2212x1659: 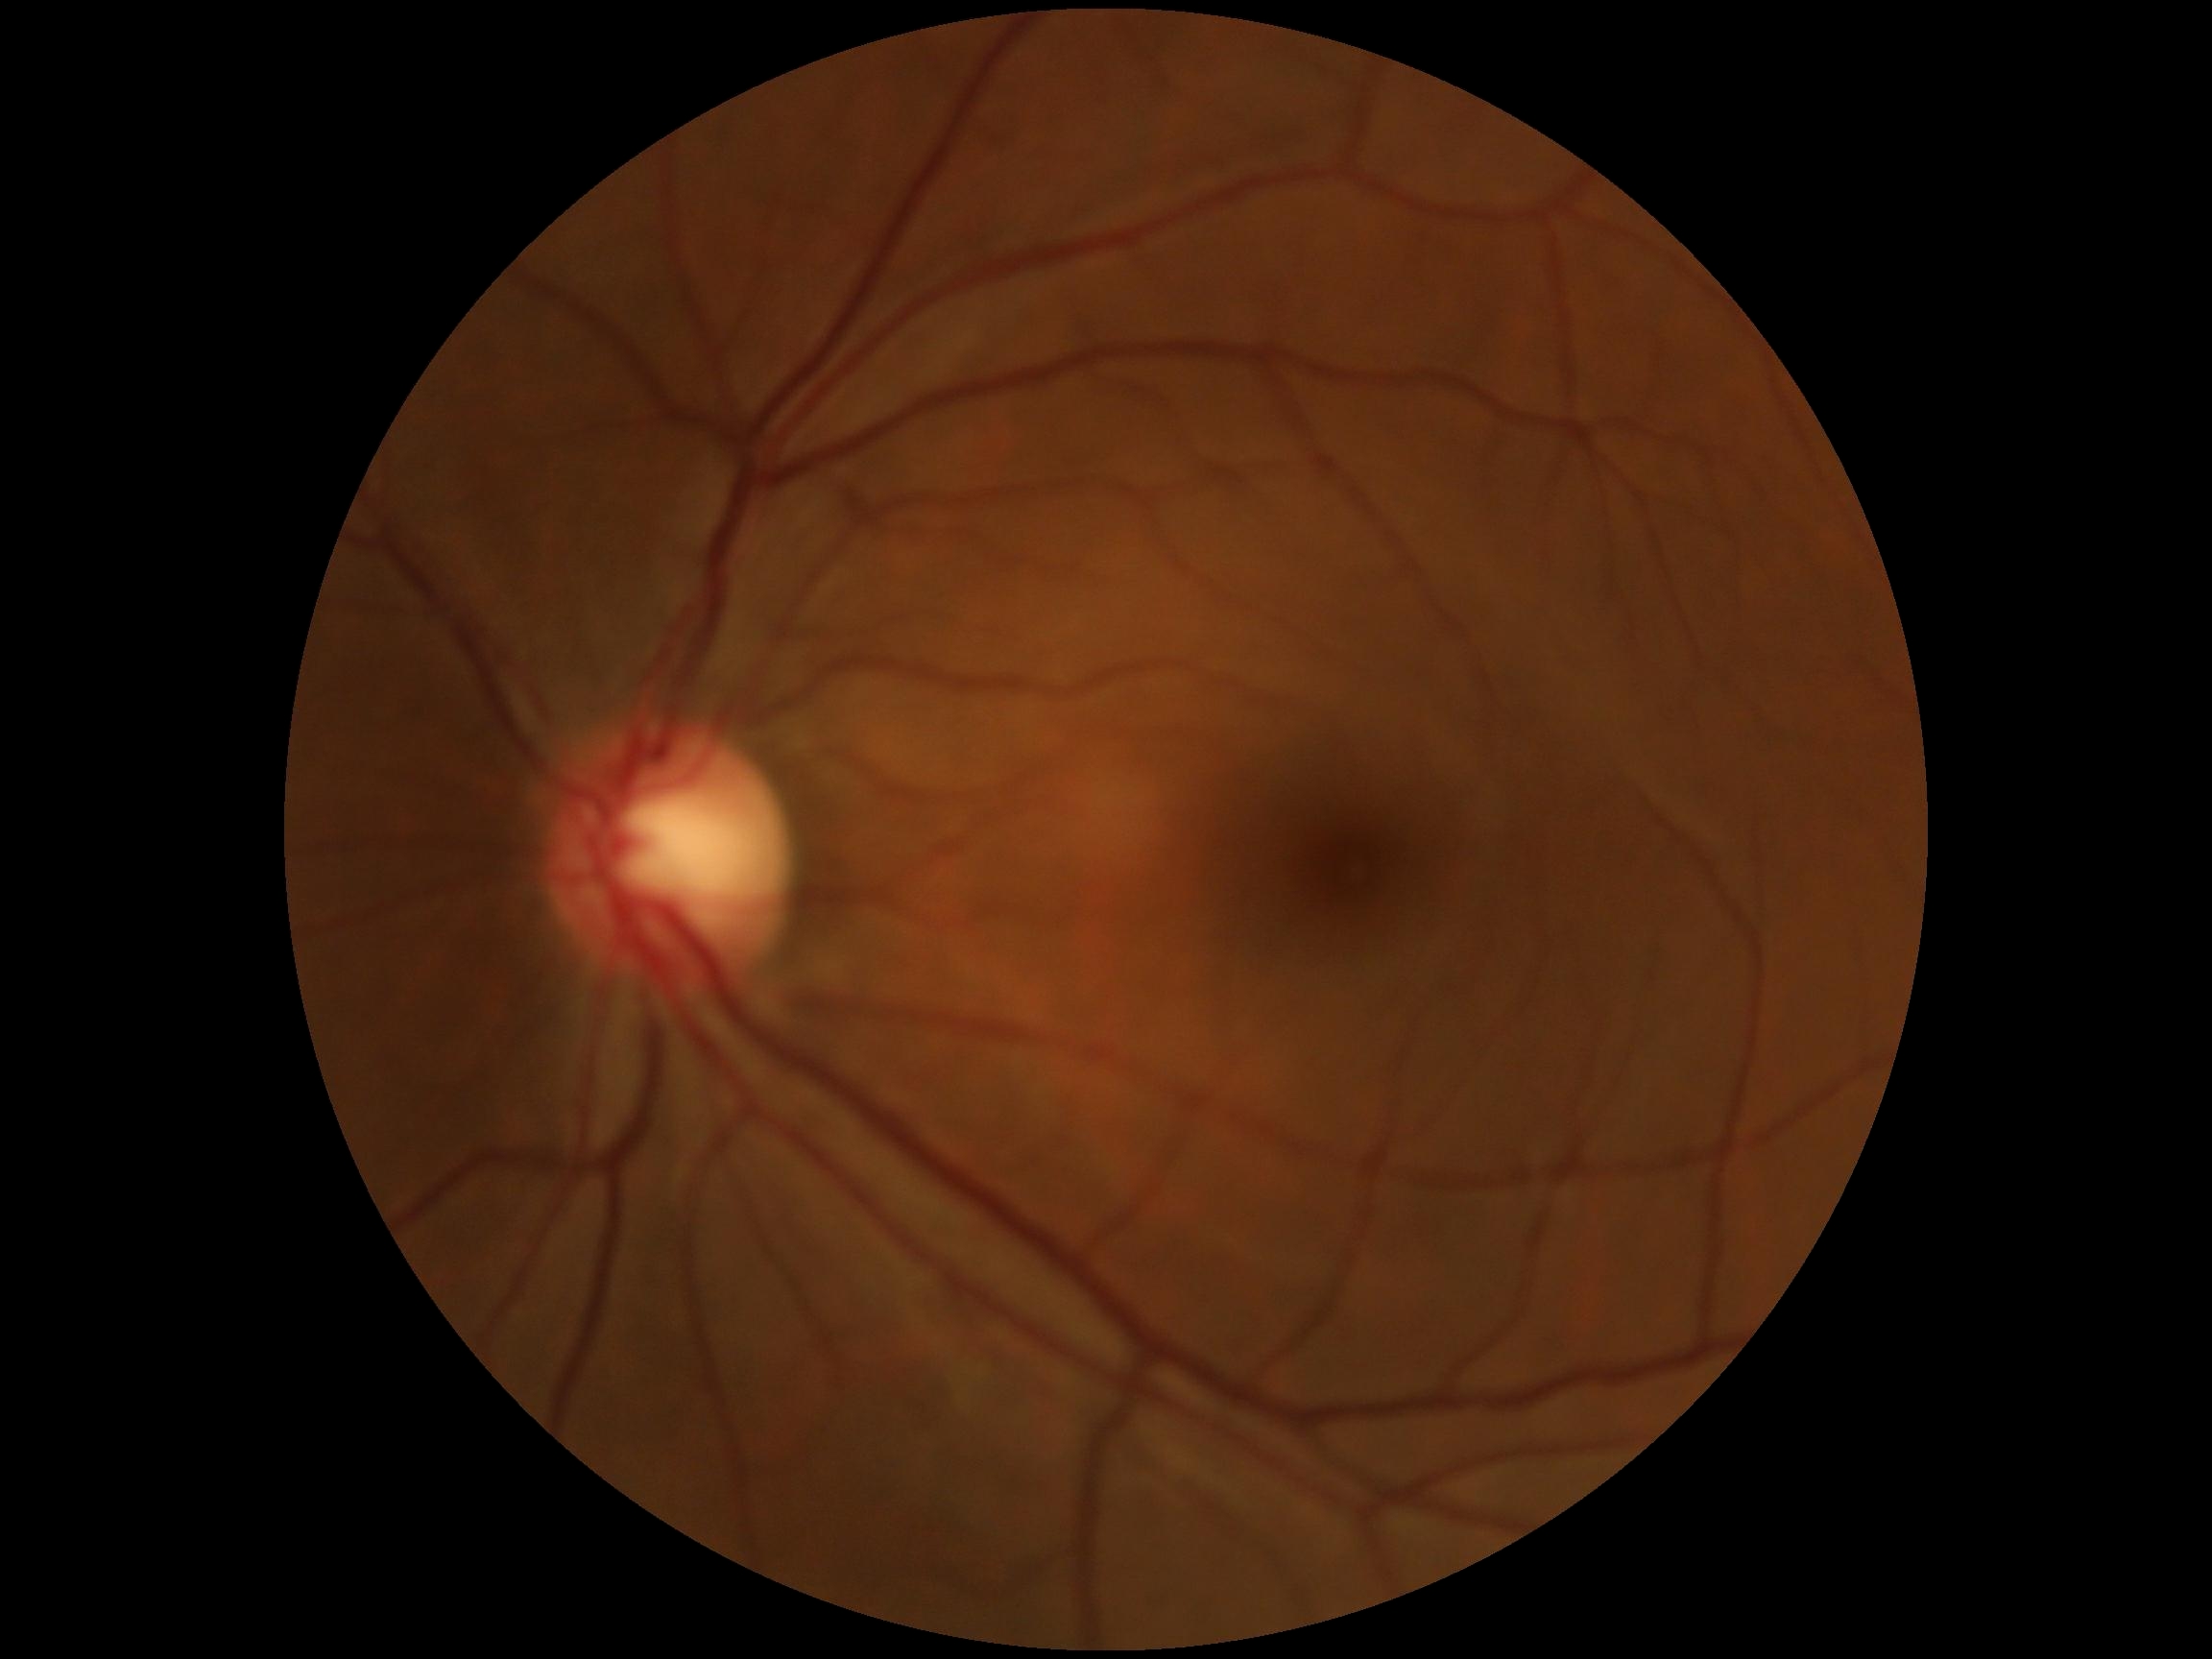
DR severity@no apparent diabetic retinopathy (grade 0).